45-degree field of view:
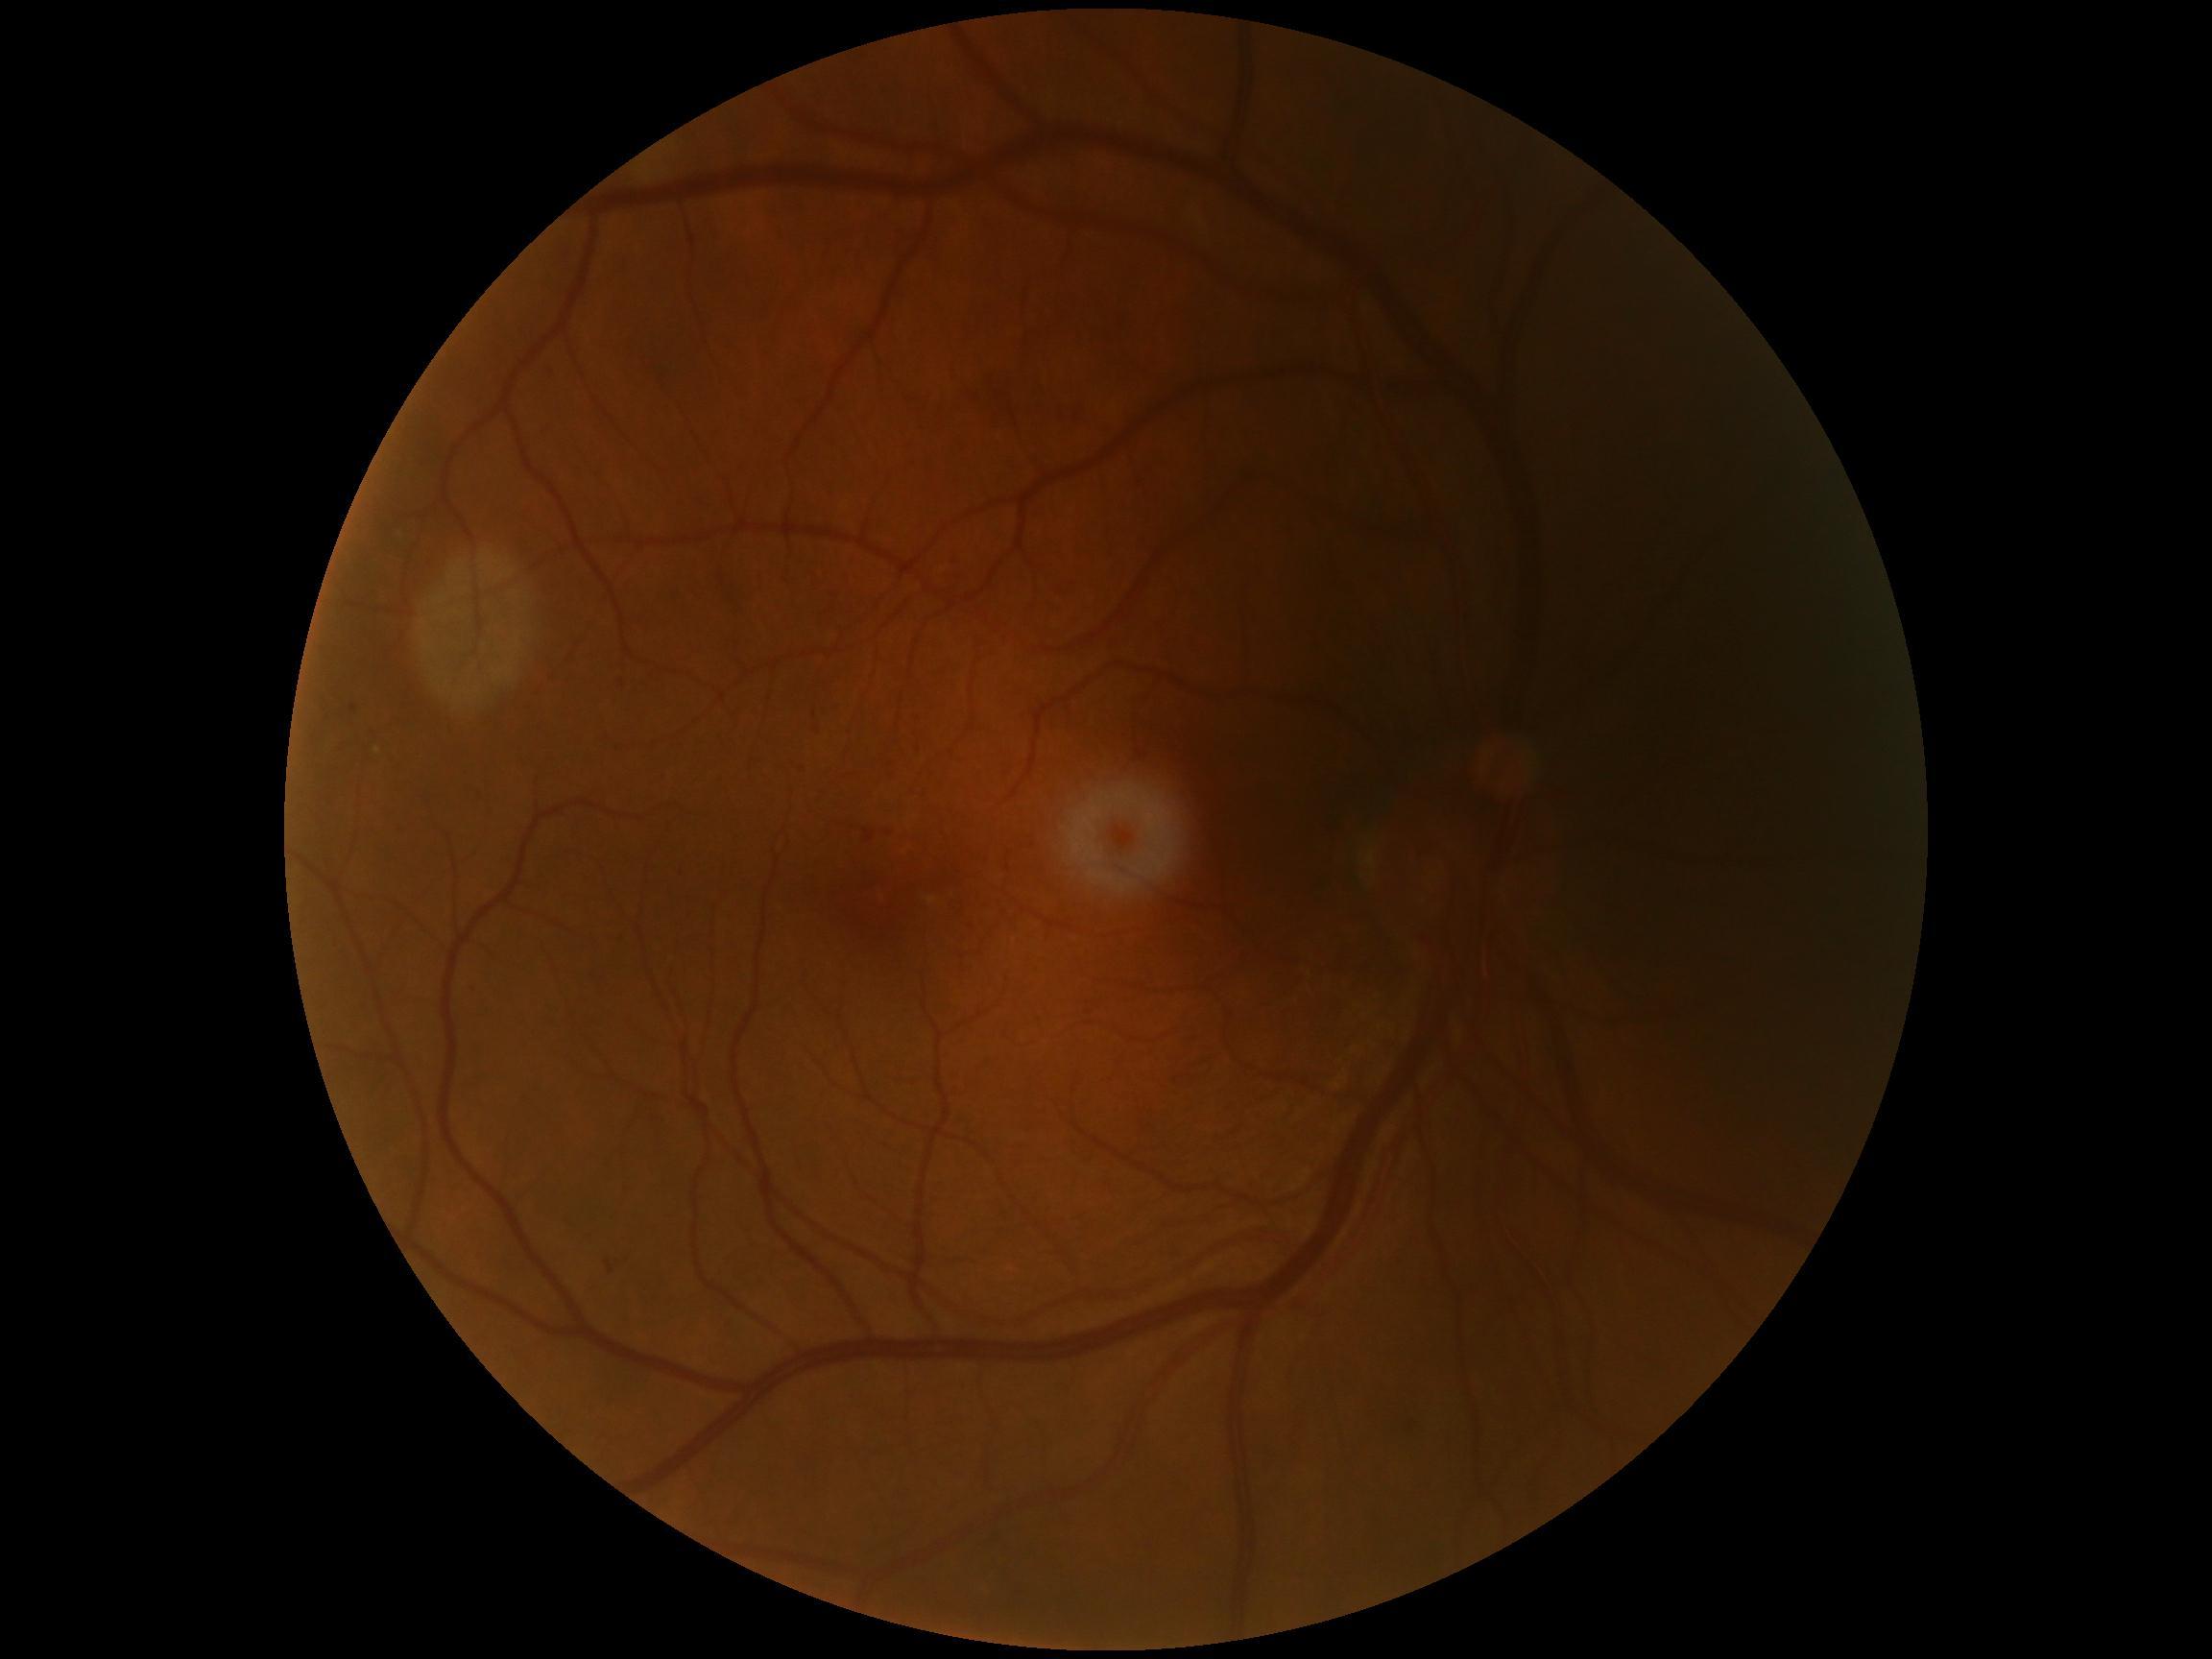
DR class: non-proliferative diabetic retinopathy.
Diabetic retinopathy grade: moderate non-proliferative diabetic retinopathy (2).